FOV: 45 degrees; fundus photo.
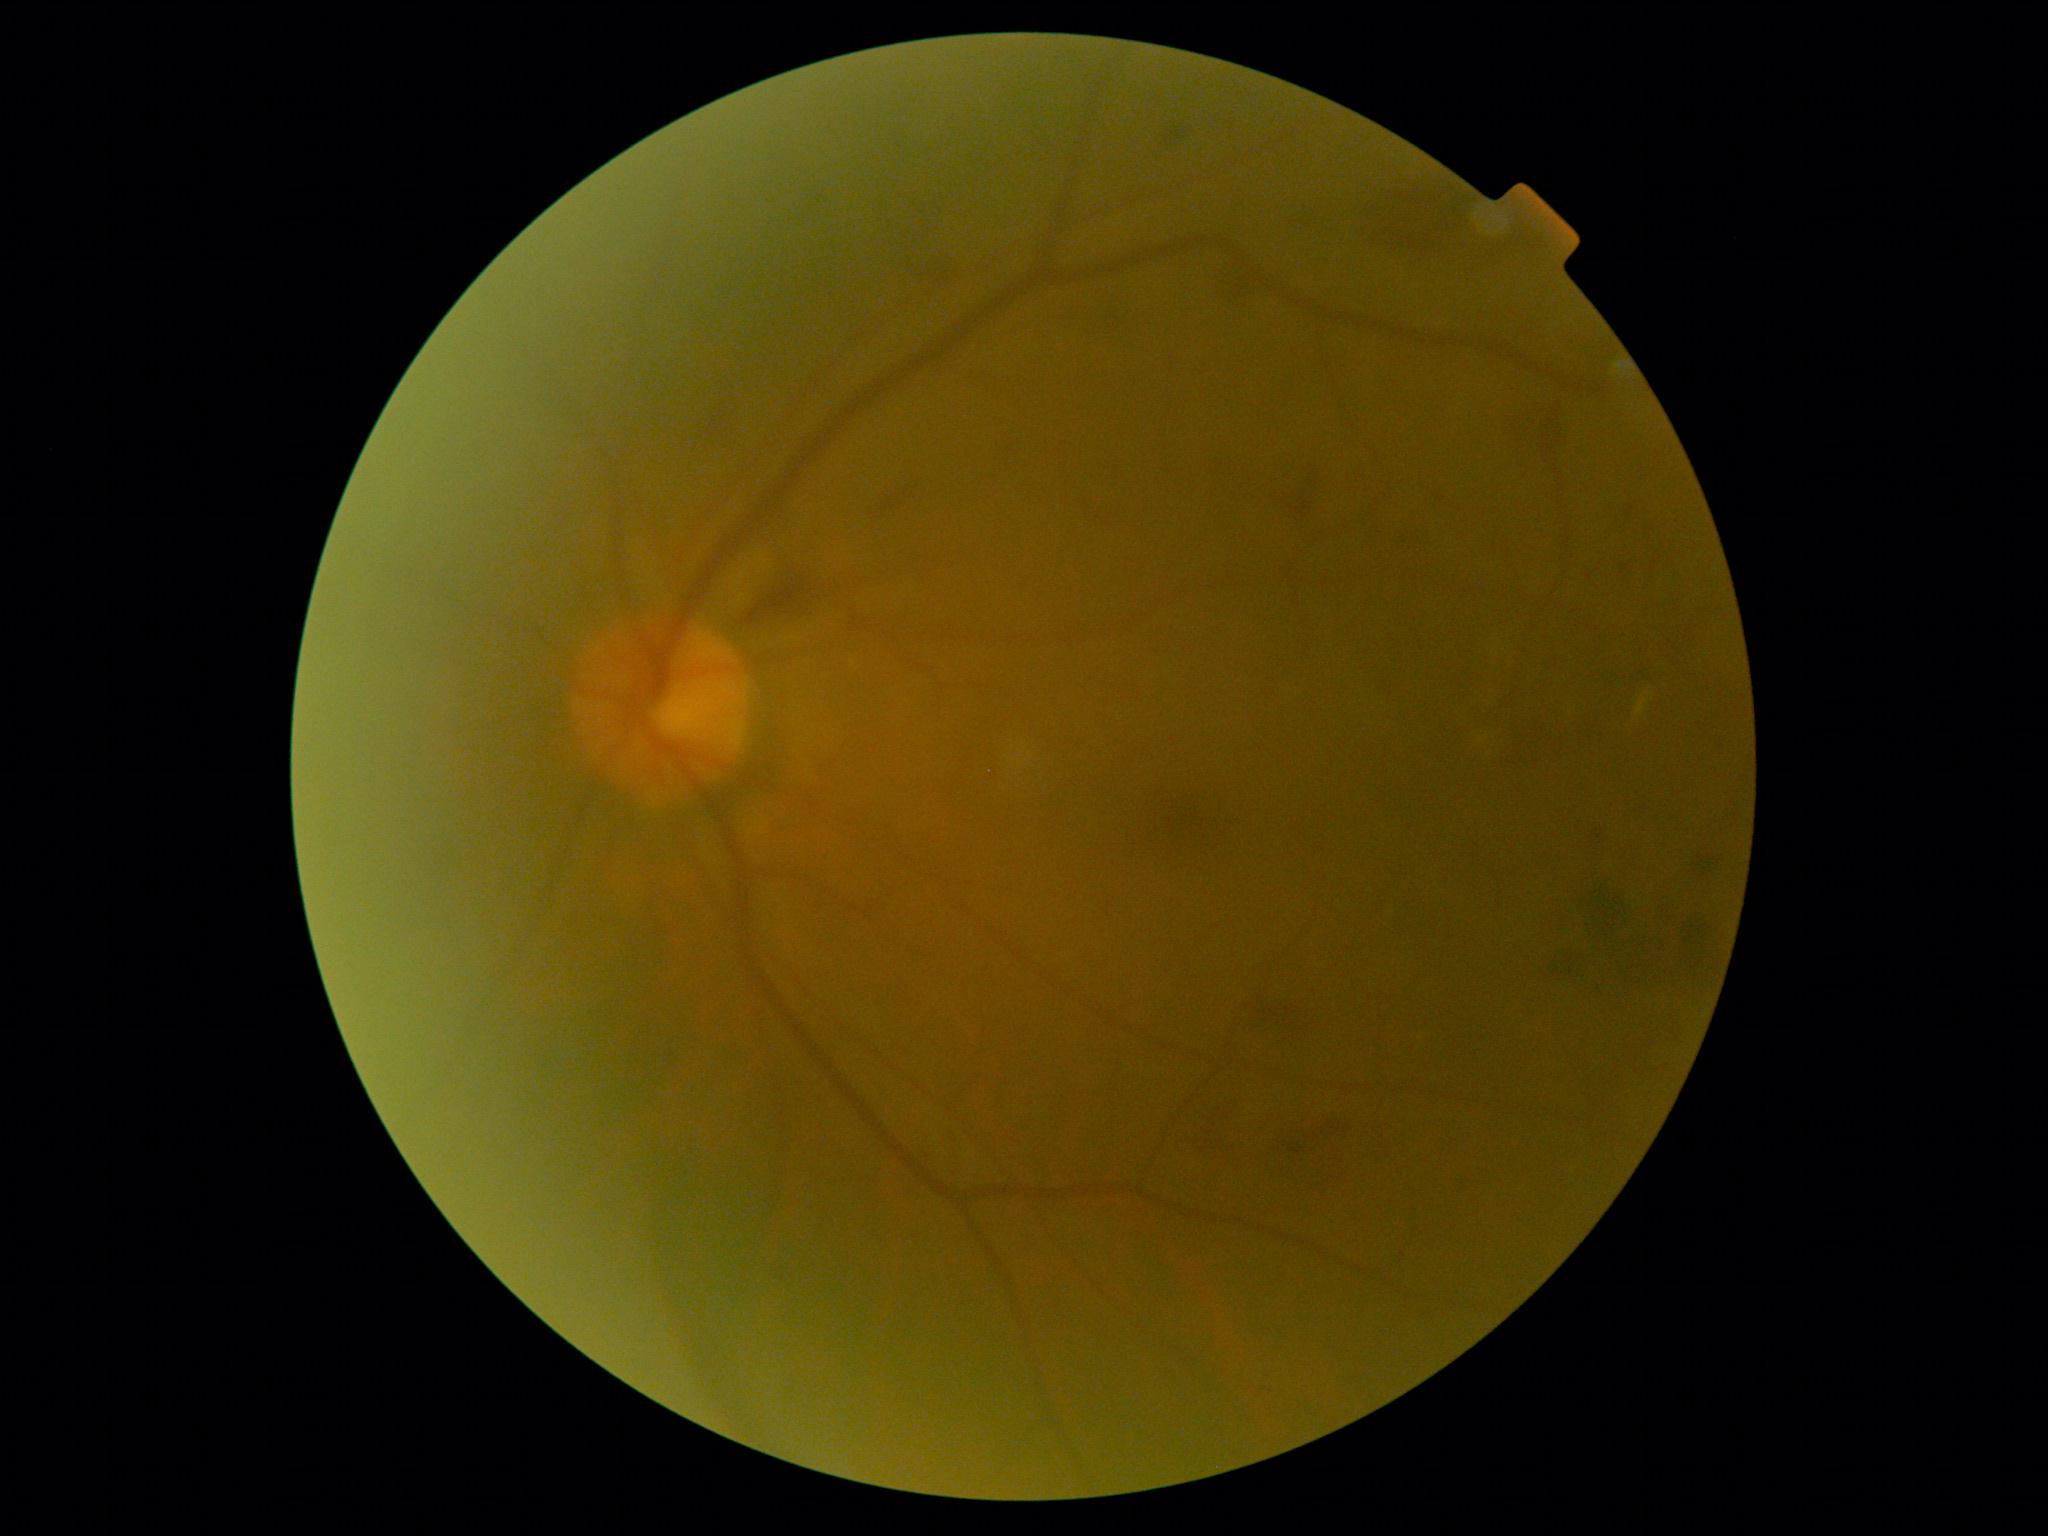

DR class: non-proliferative diabetic retinopathy. Retinopathy grade is 2.